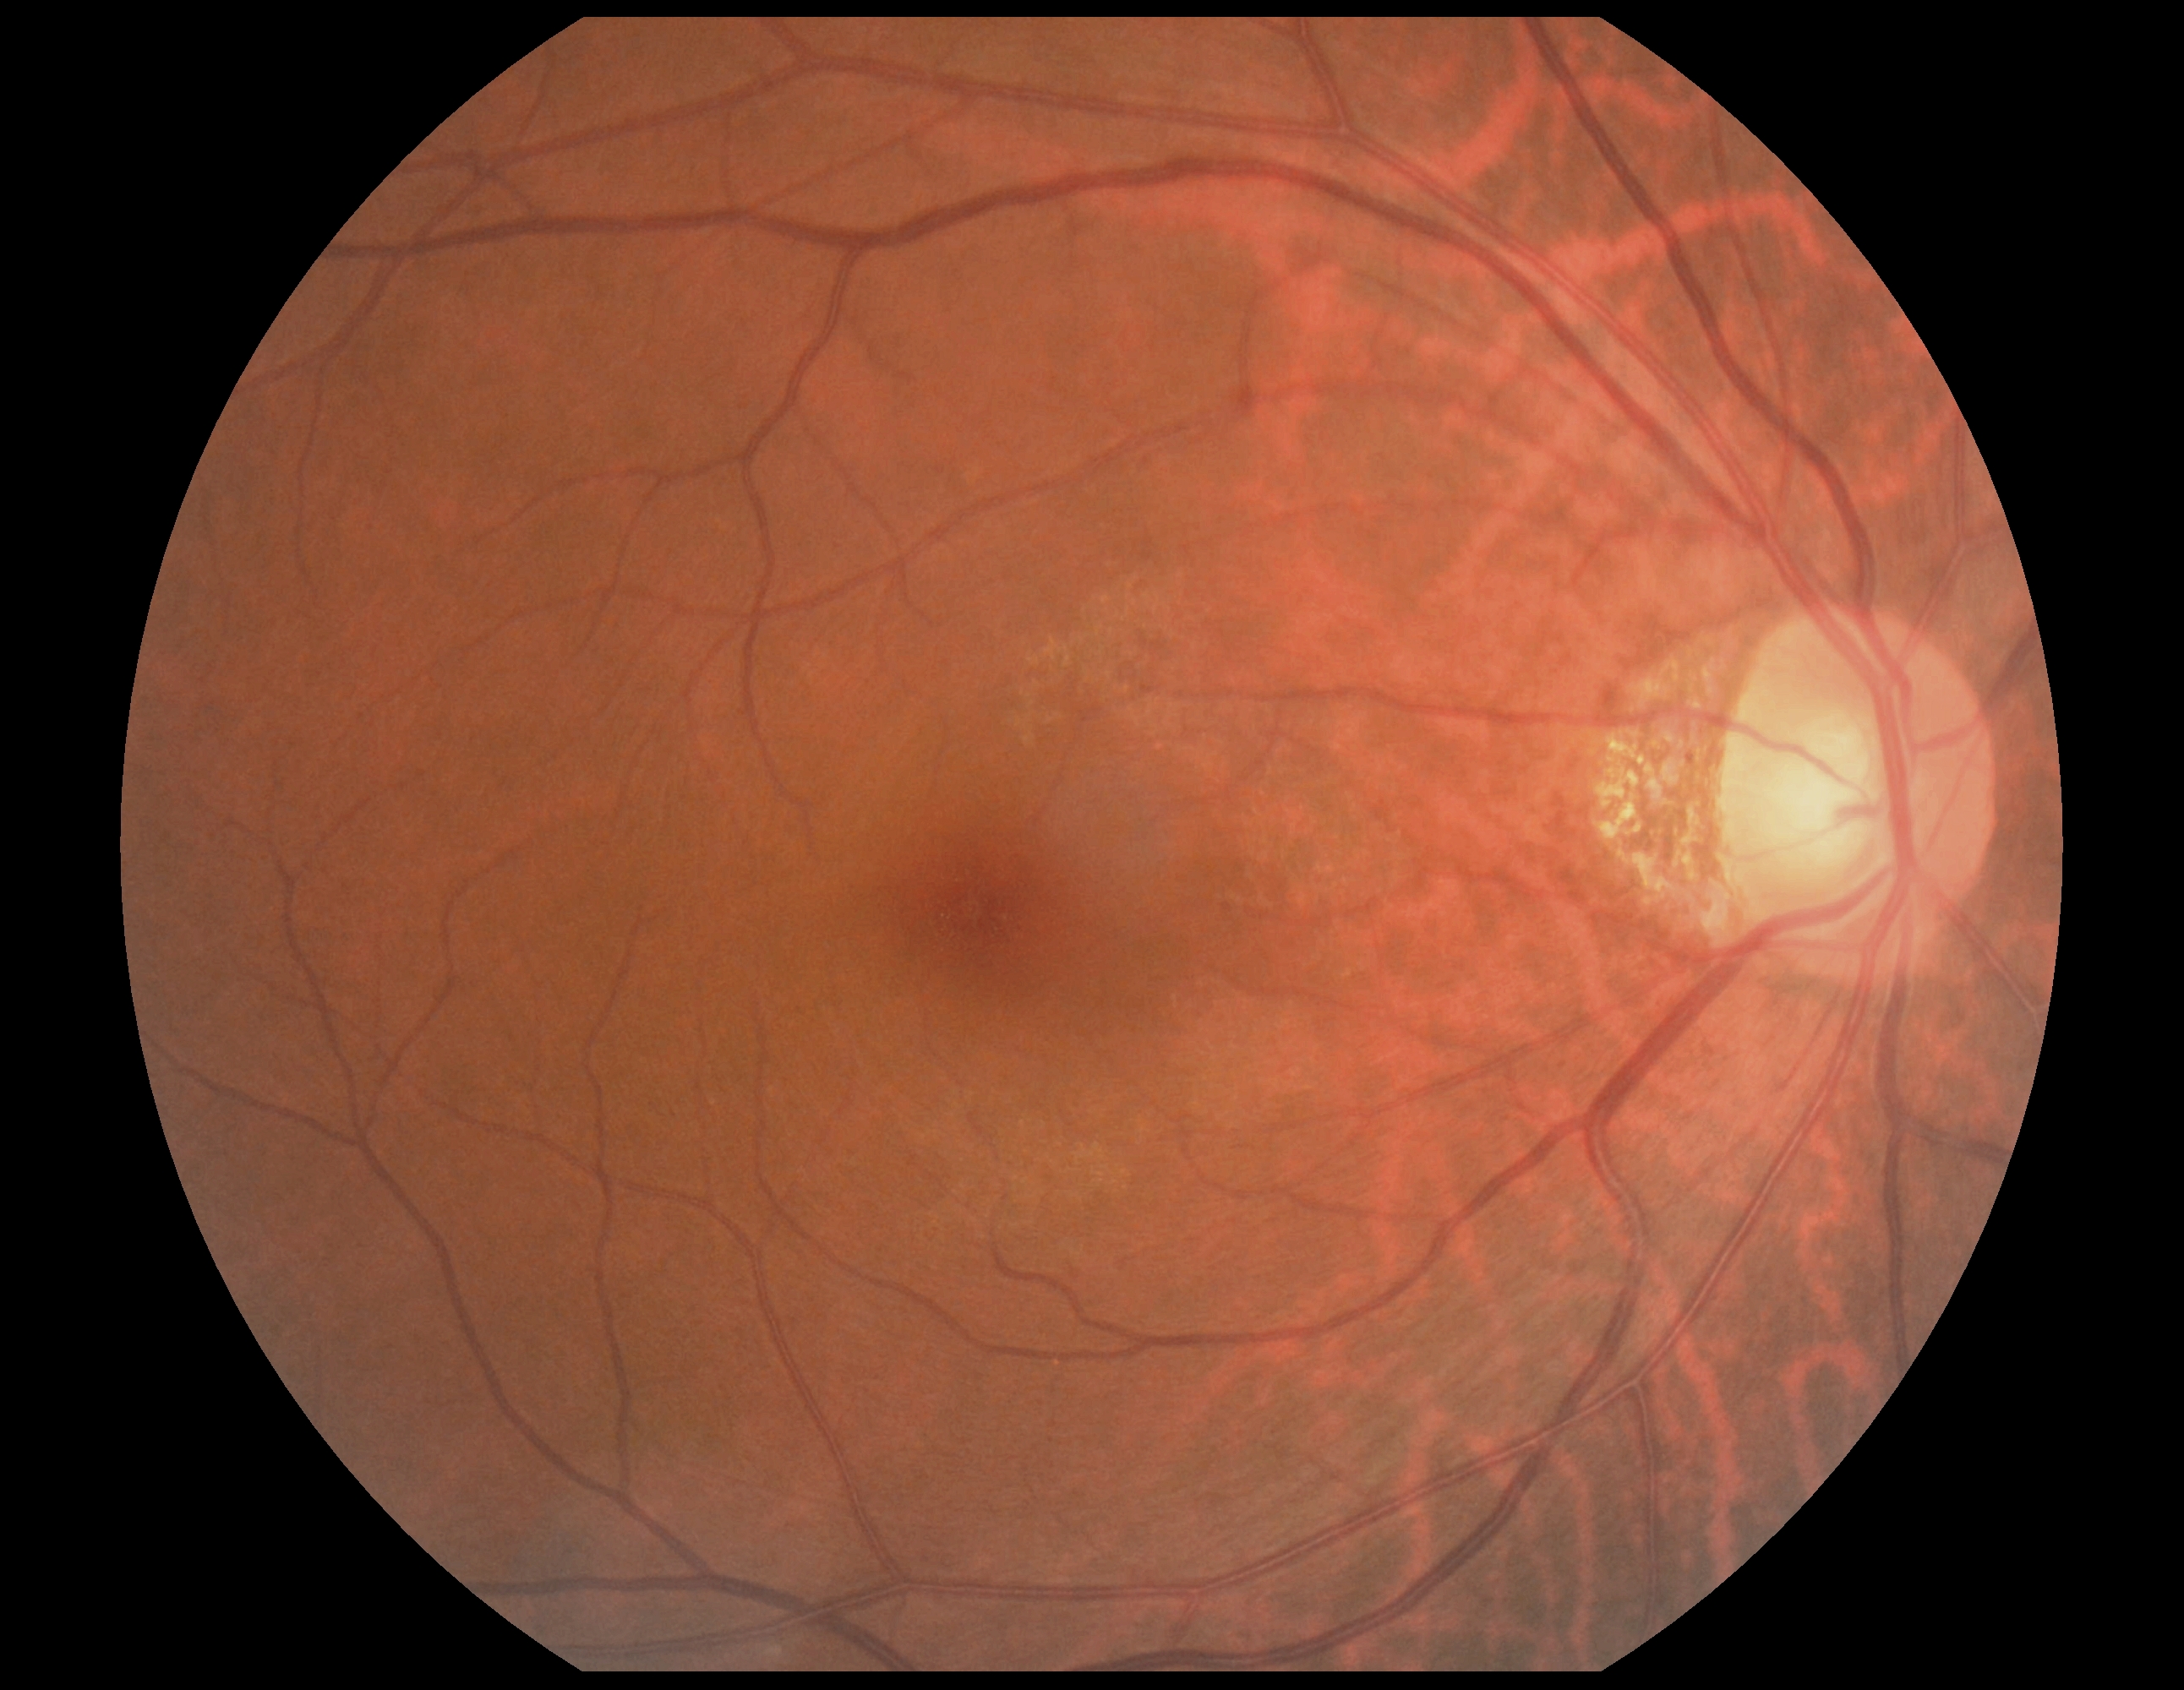

DR grade: 0 (no apparent retinopathy).